45° field of view
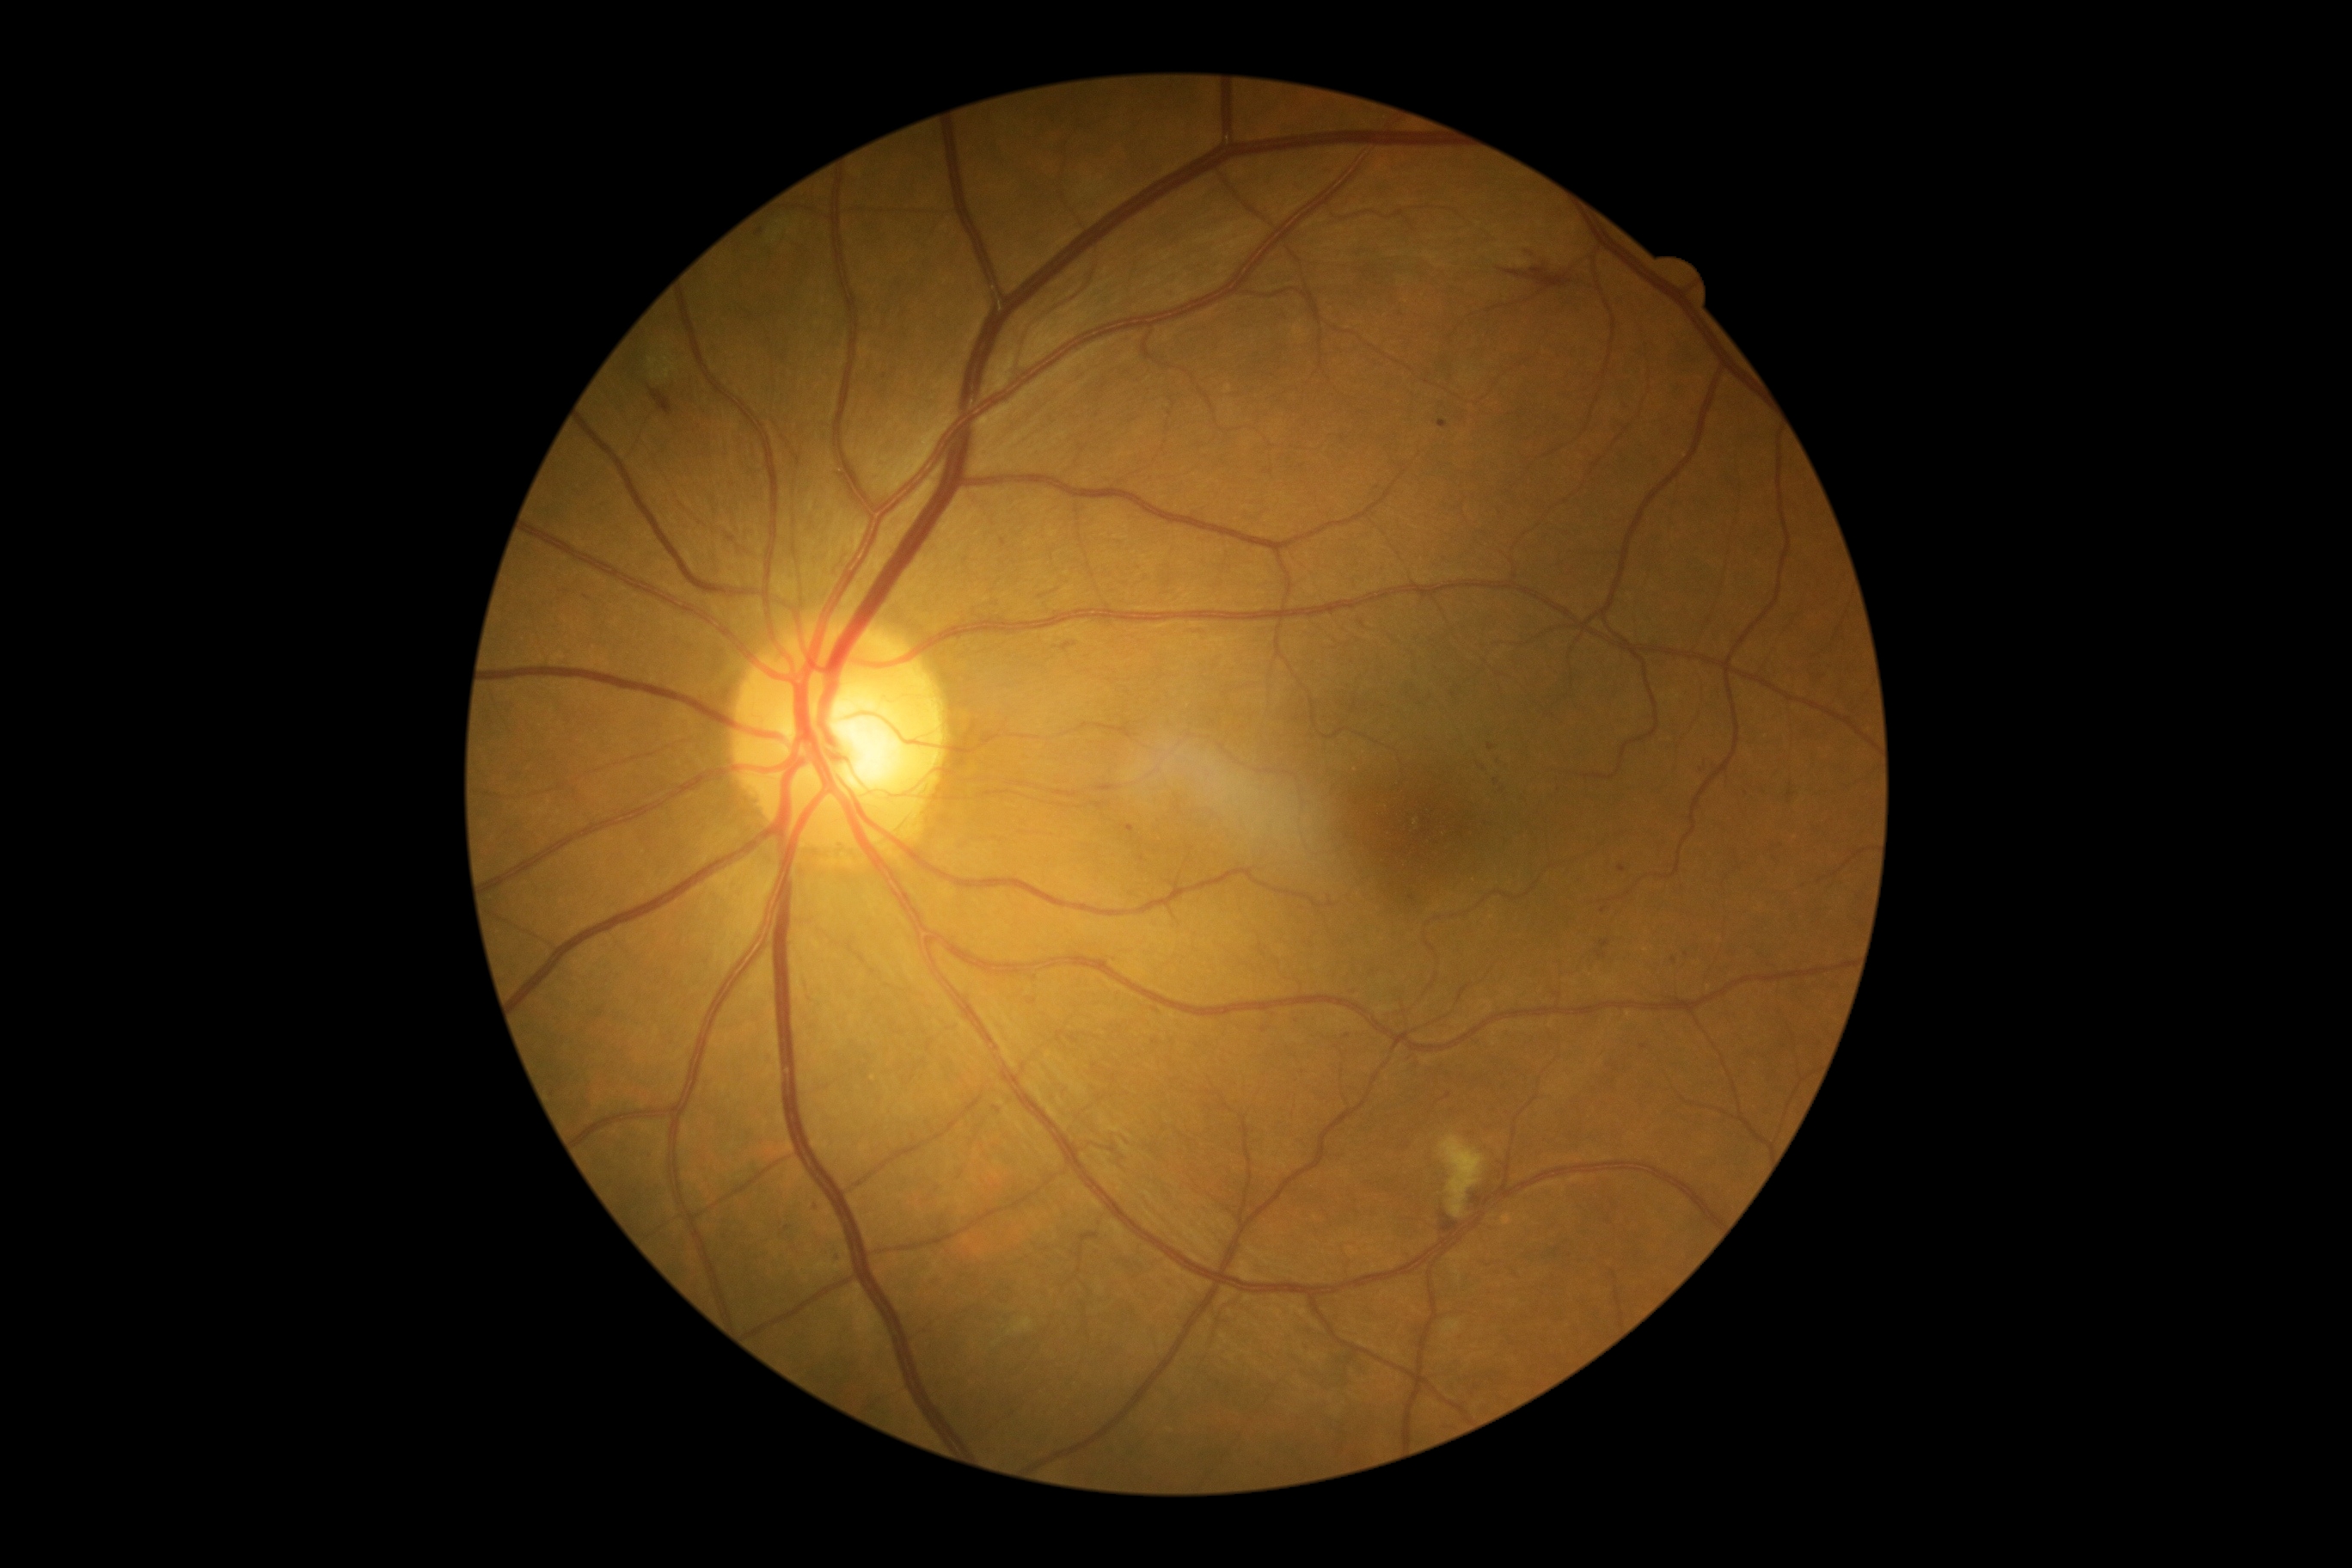
DR severity is grade 2 (moderate NPDR)
Selected lesions:
MAs (more not shown): [left=1438, top=420, right=1449, bottom=429], [left=1168, top=291, right=1179, bottom=302], [left=1602, top=940, right=1610, bottom=948], [left=1127, top=824, right=1134, bottom=833]
MAs (small, approximate centers) near x=759, y=233, x=1674, y=961, x=838, y=1261, x=1495, y=782, x=1687, y=955, x=1449, y=1096, x=1501, y=760, x=1264, y=1029, x=1562, y=793, x=787, y=1228
SEs: none identified
HEs: [left=1521, top=242, right=1533, bottom=260], [left=1500, top=267, right=1572, bottom=290], [left=647, top=386, right=673, bottom=415], [left=1471, top=1194, right=1485, bottom=1208], [left=1442, top=1213, right=1459, bottom=1232]
EXs: [left=1008, top=1320, right=1032, bottom=1335], [left=1443, top=1320, right=1462, bottom=1337], [left=1440, top=1136, right=1486, bottom=1218]